Modified Davis grading: 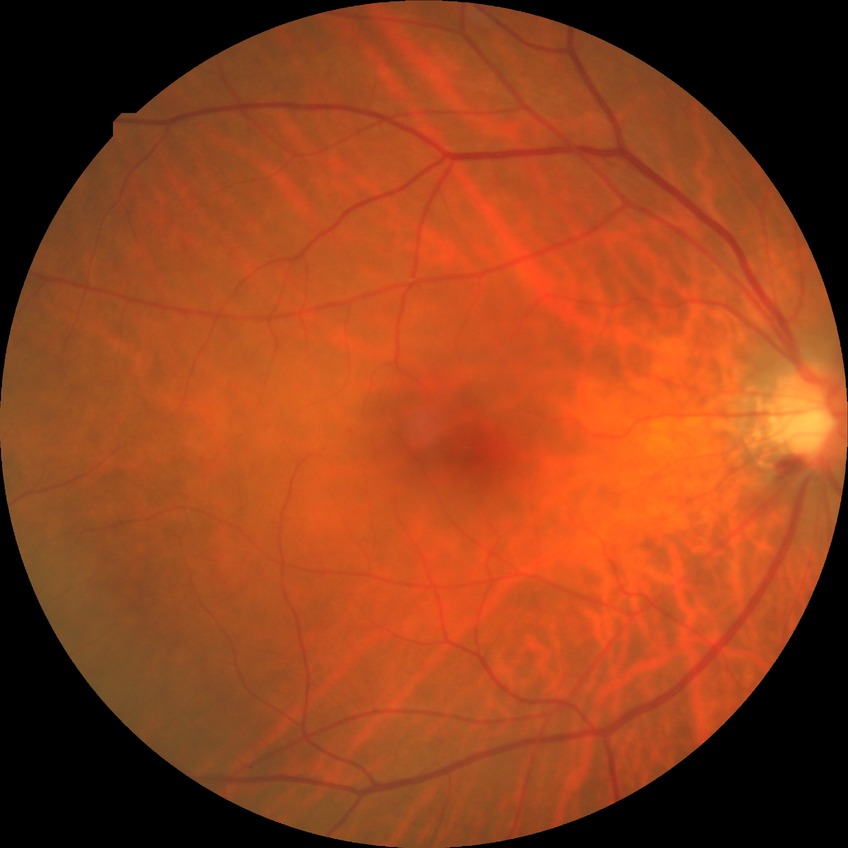

Retinopathy stage is no diabetic retinopathy.